Color fundus image: 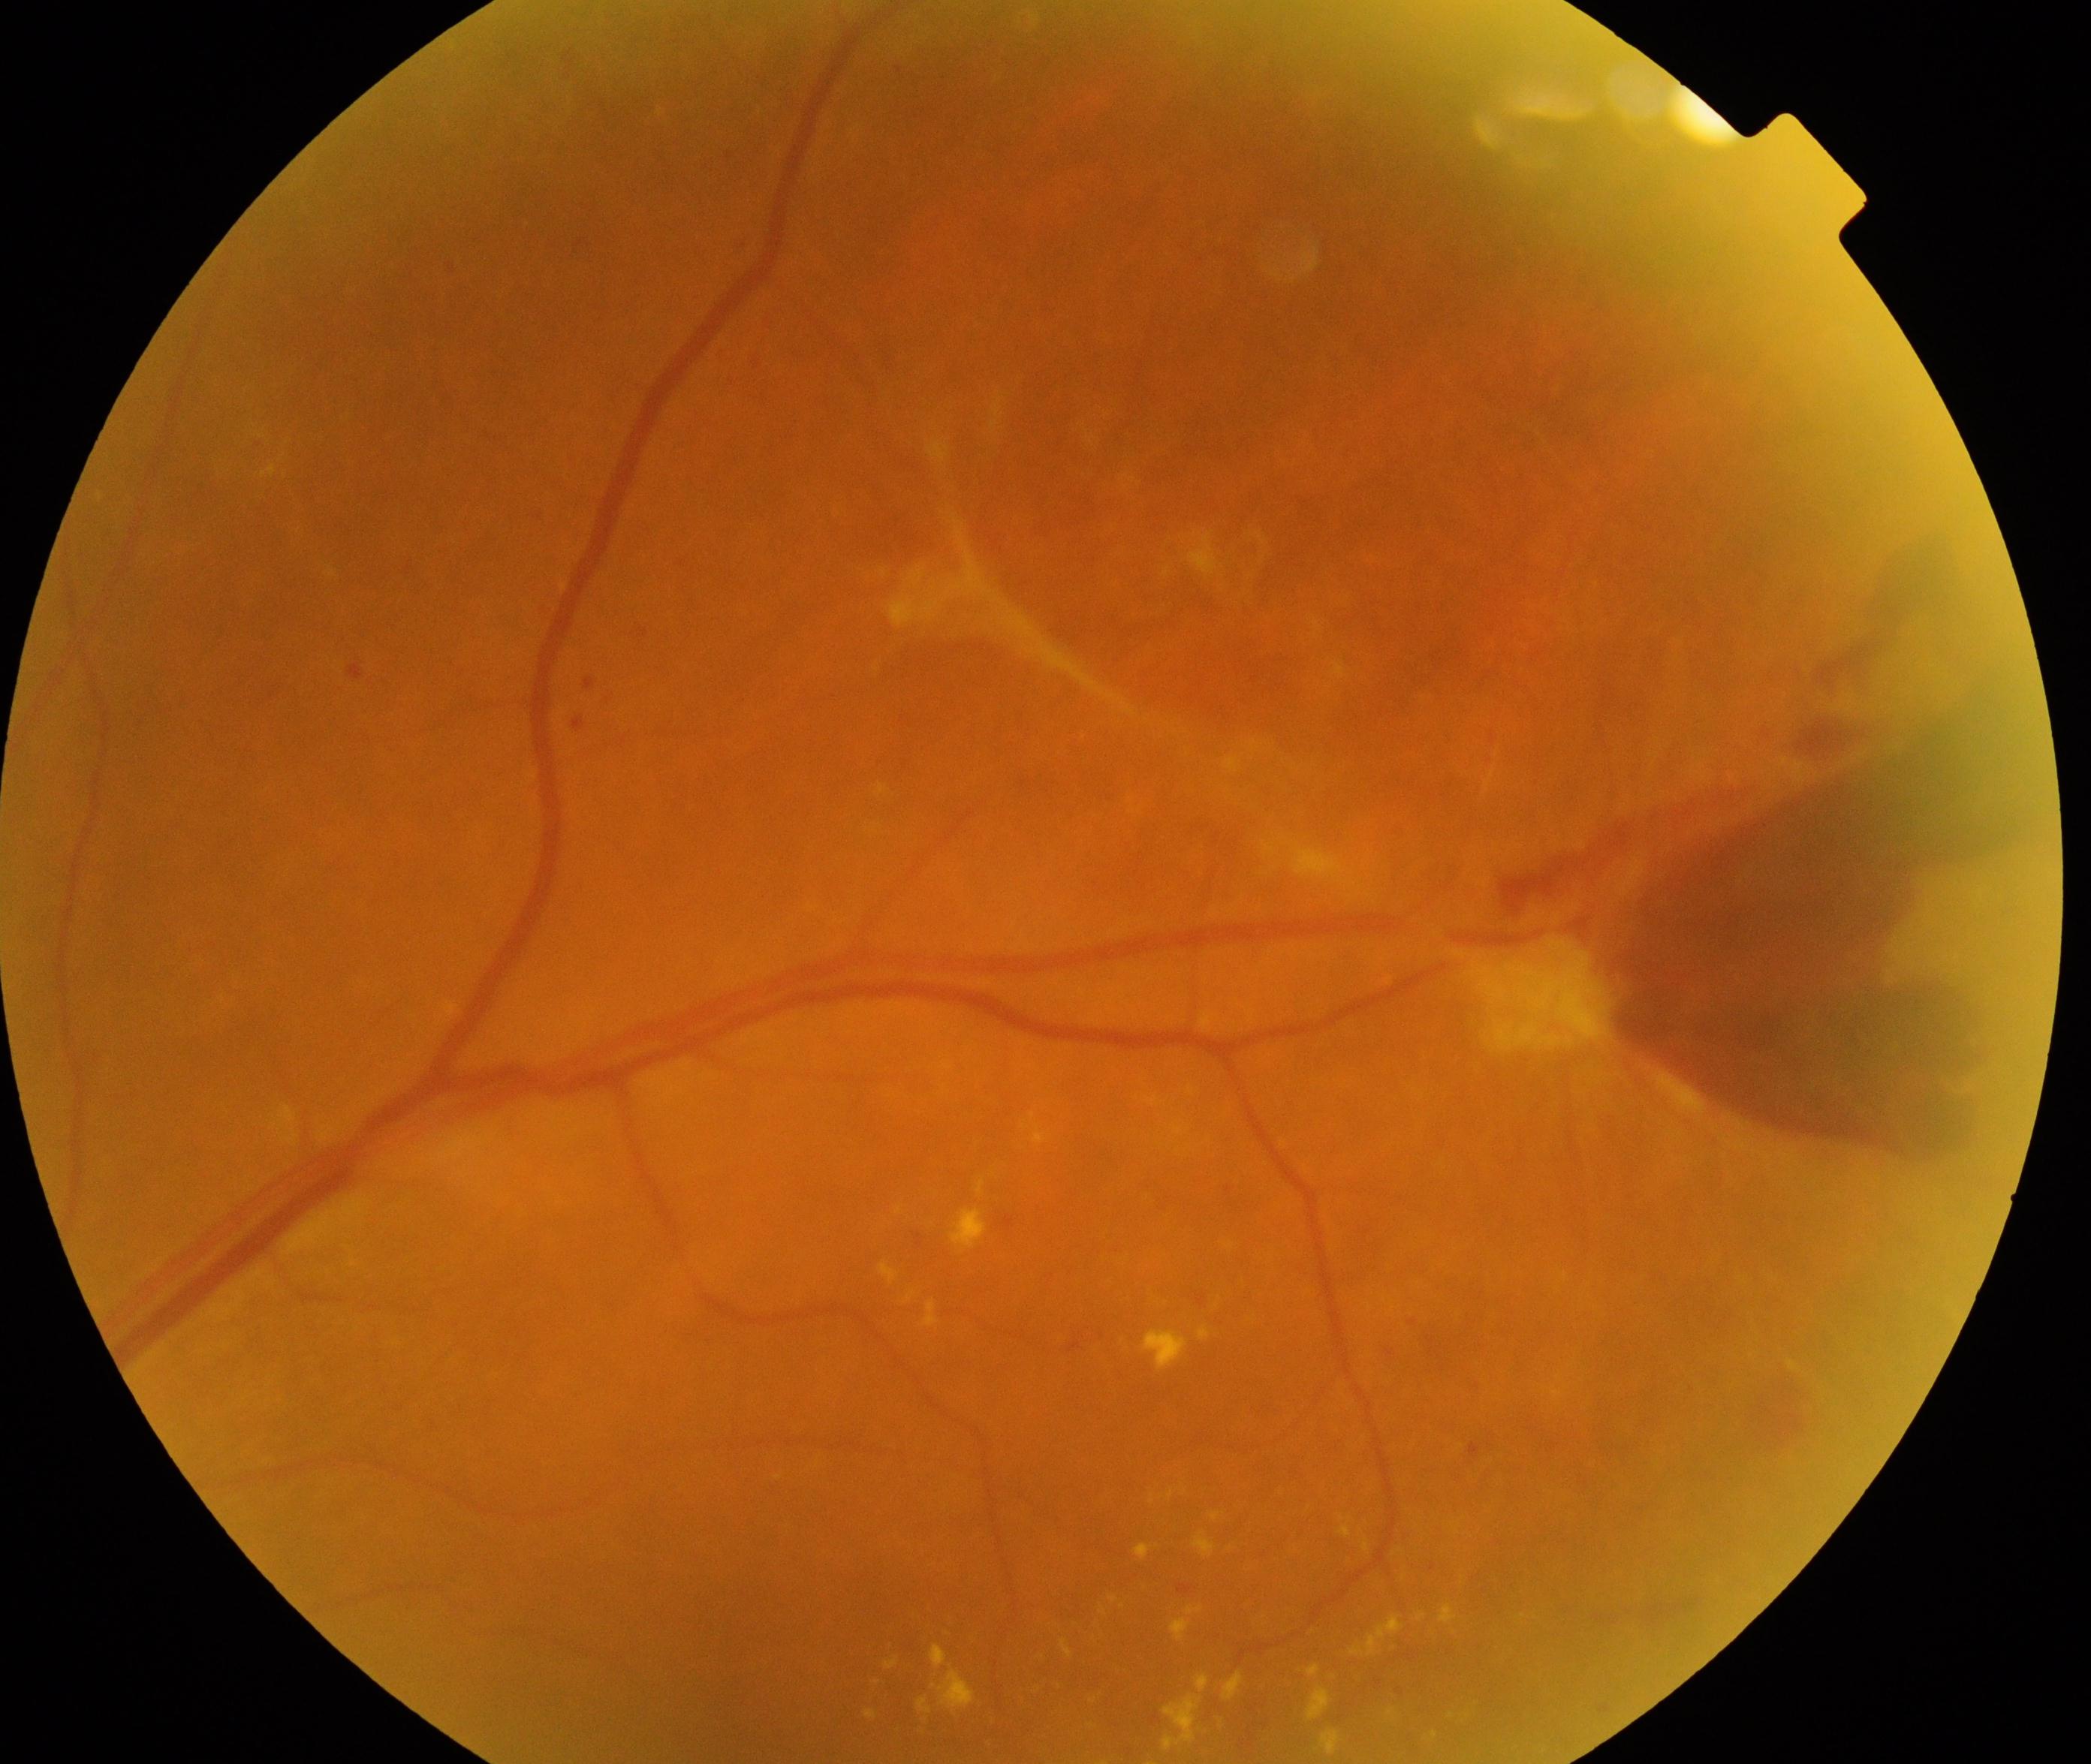 There is evidence of severe non-proliferative or proliferative diabetic retinopathy.